130° field of view (Clarity RetCam 3) · 640 x 480 pixels · wide-field fundus photograph from neonatal ROP screening — 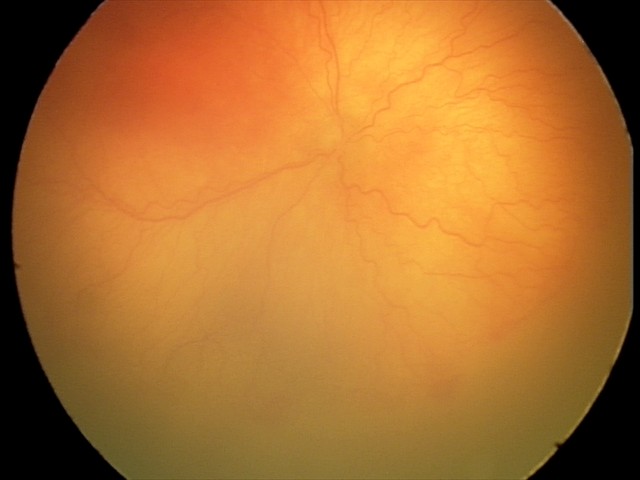

Screening examination consistent with aggressive retinopathy of prematurity.